Pediatric retinal photograph (wide-field).
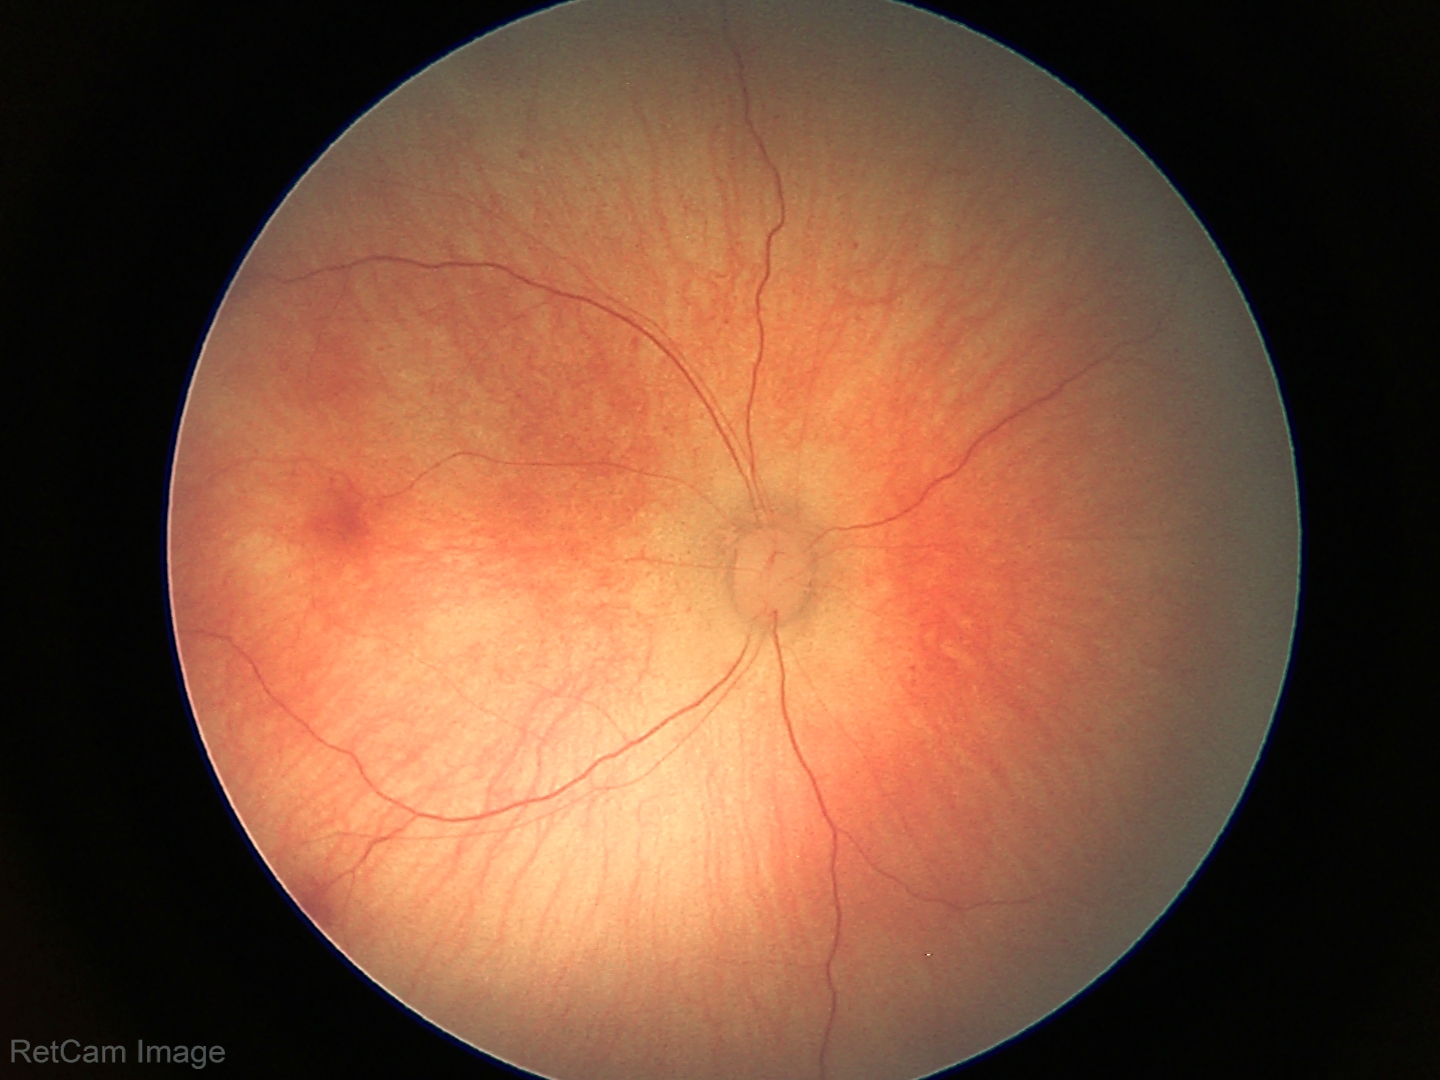
Series diagnosed as retinal hemorrhages.